Pediatric wide-field fundus photograph.
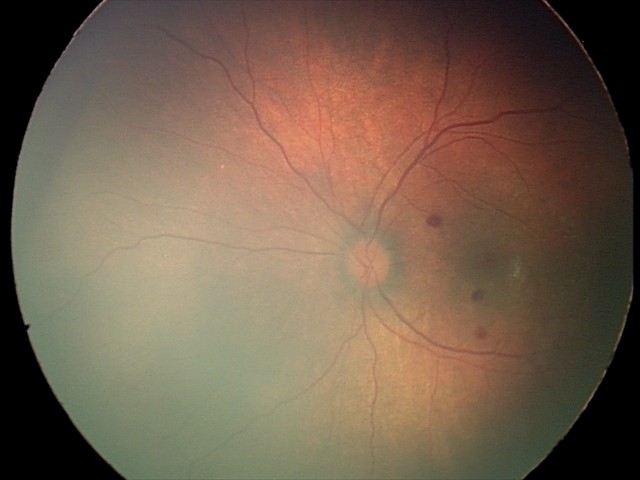 Screening examination consistent with retinal hemorrhages.